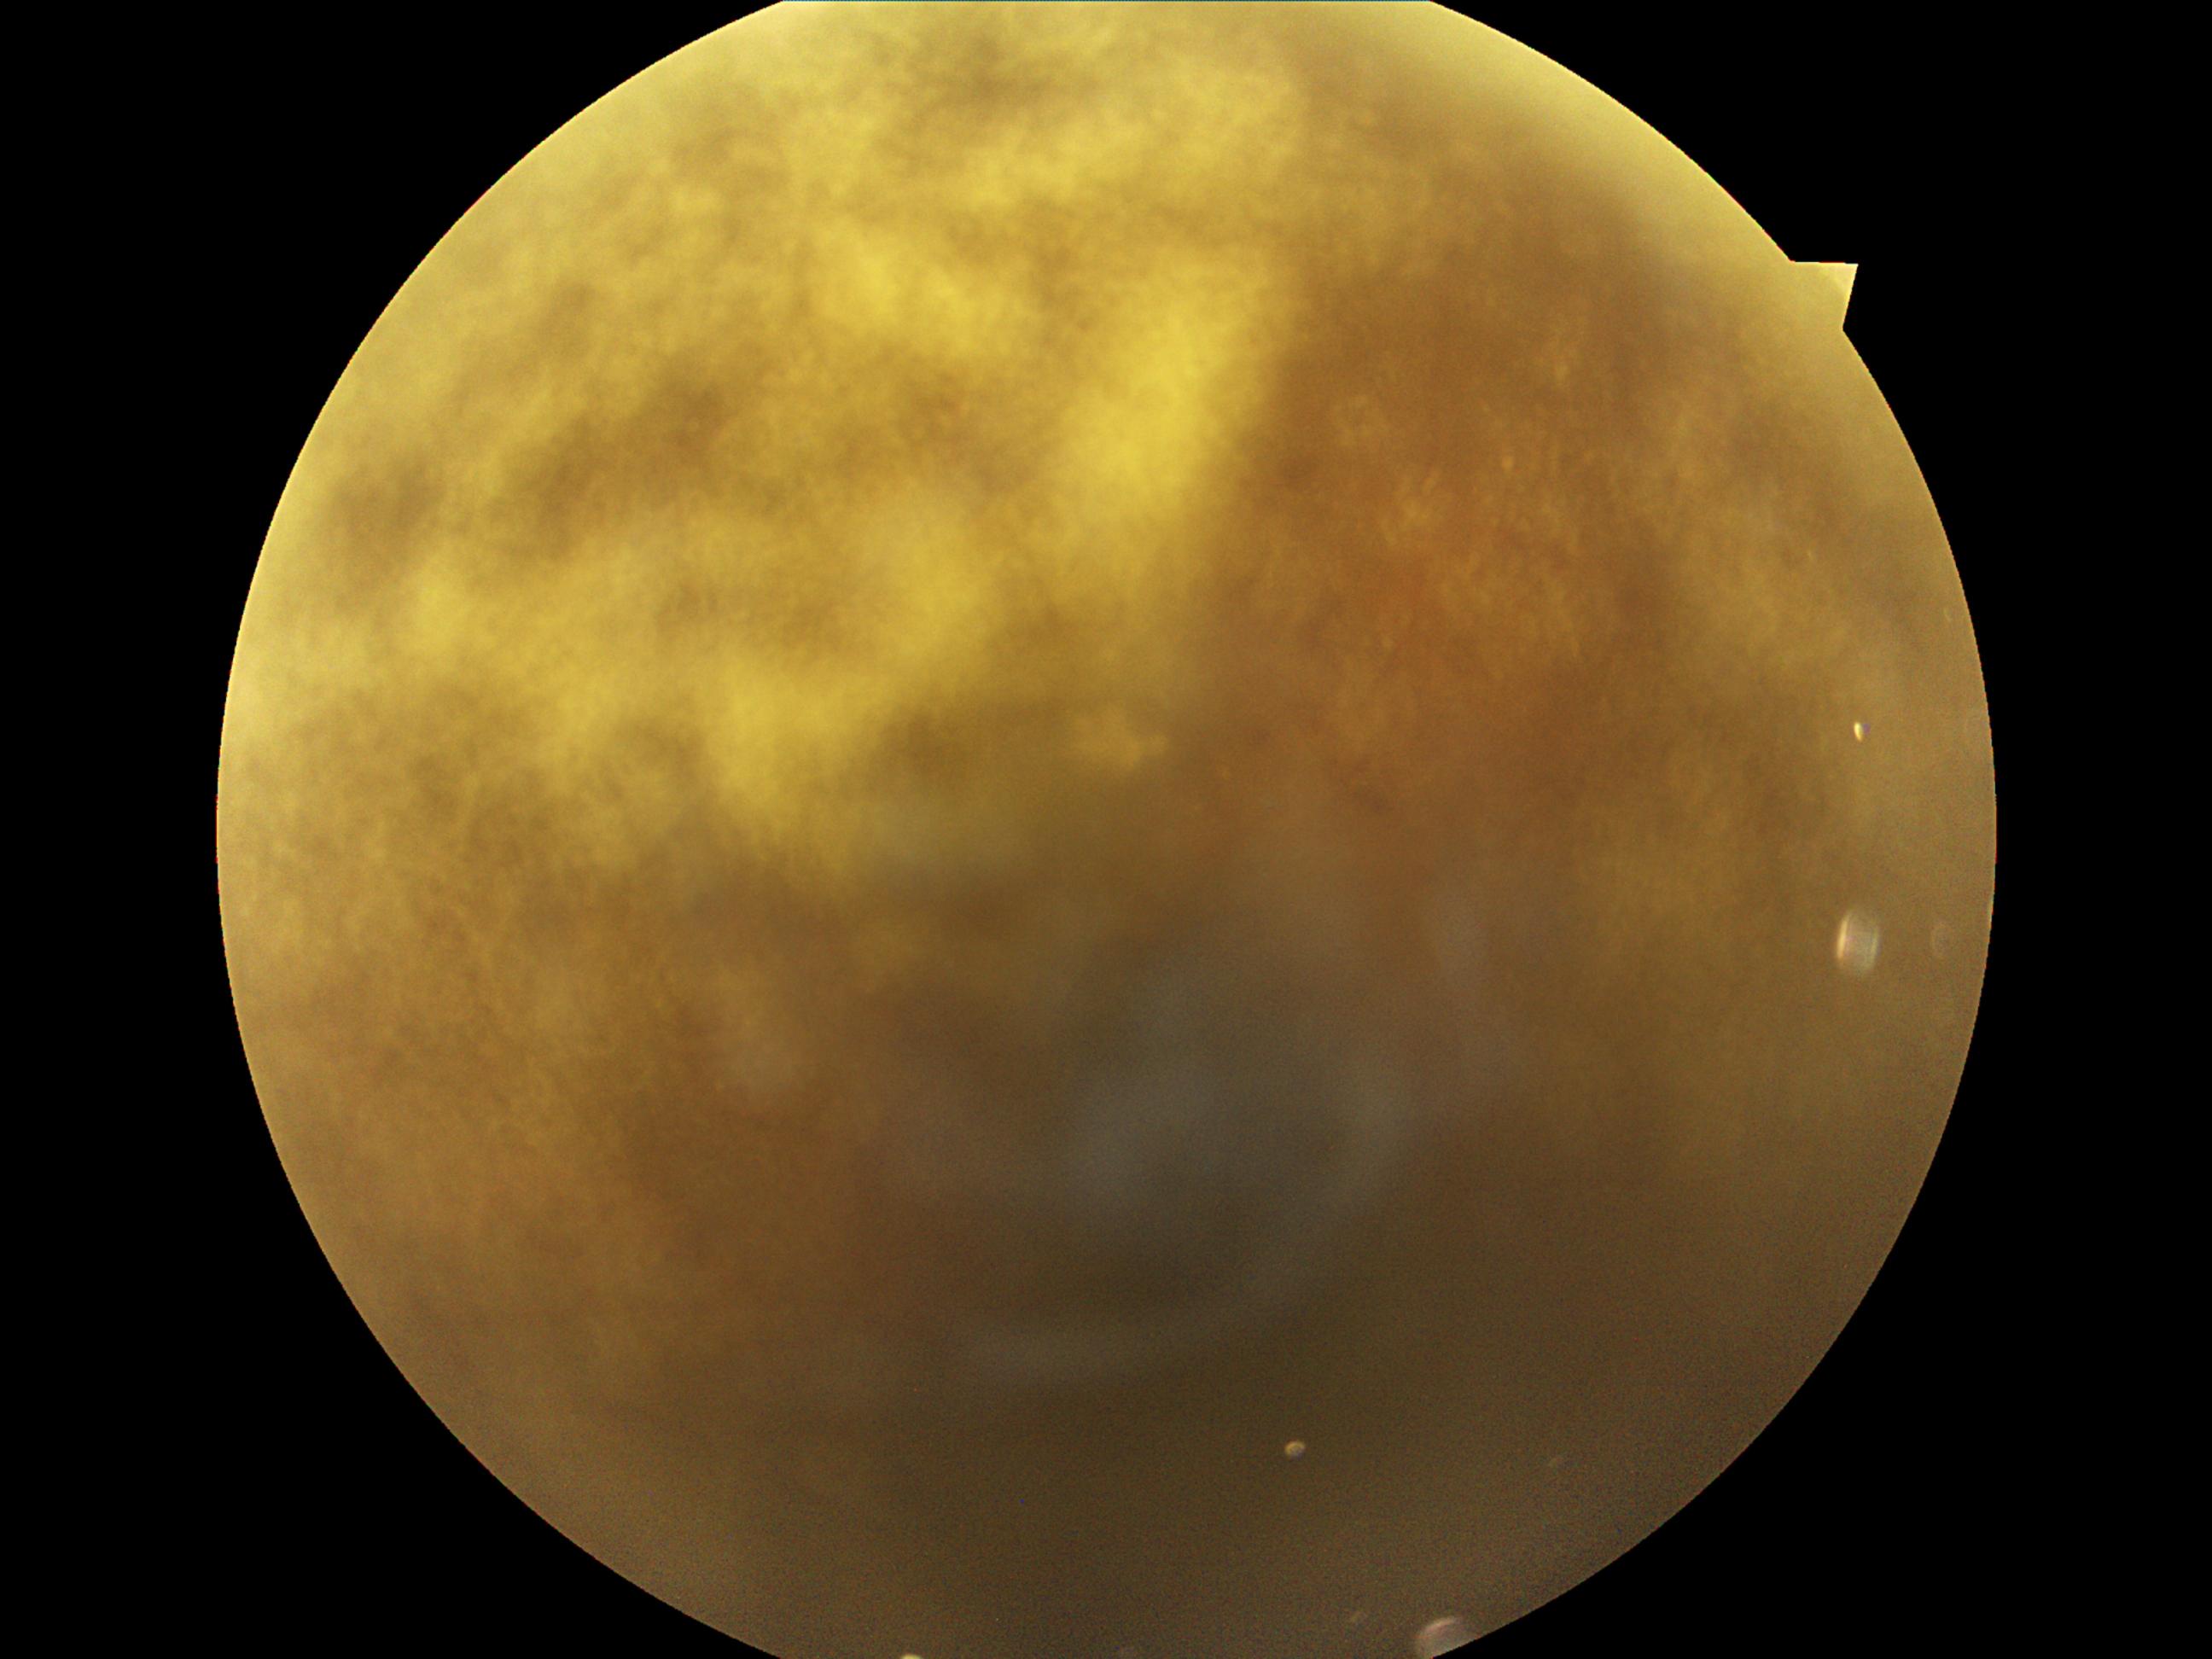
DR severity is grade 2 (moderate NPDR).
Disease class: non-proliferative diabetic retinopathy.